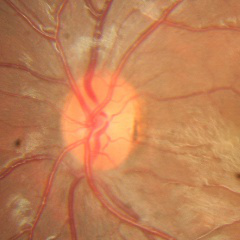
Q: Does this eye have glaucoma?
A: No glaucoma.